Modified Davis classification
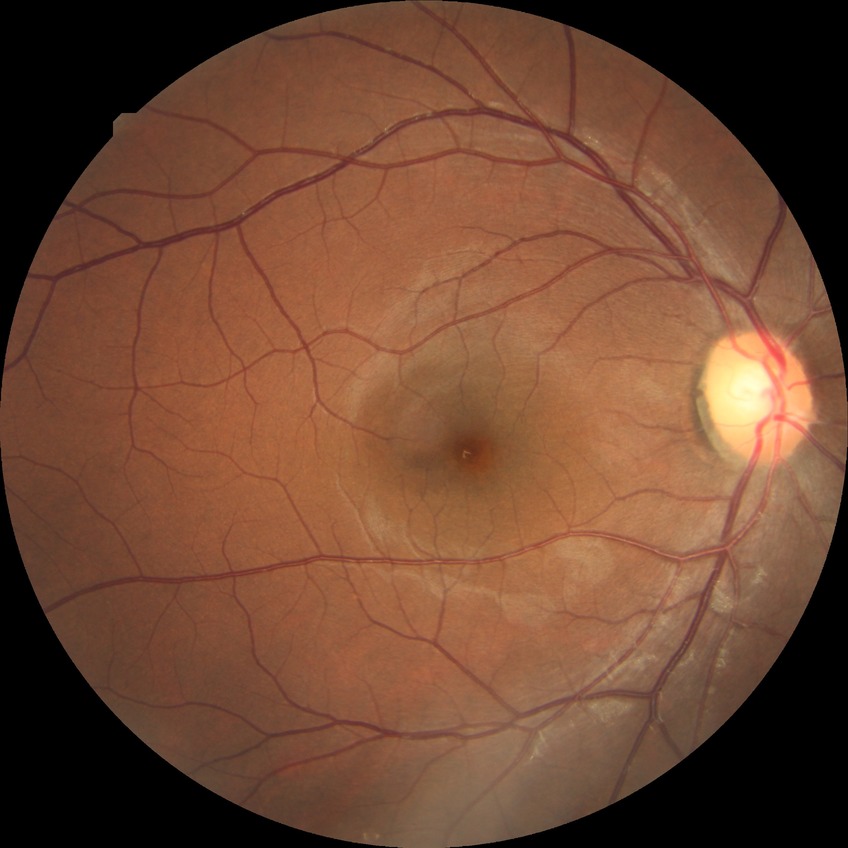 Diabetic retinopathy (DR): no diabetic retinopathy (NDR).